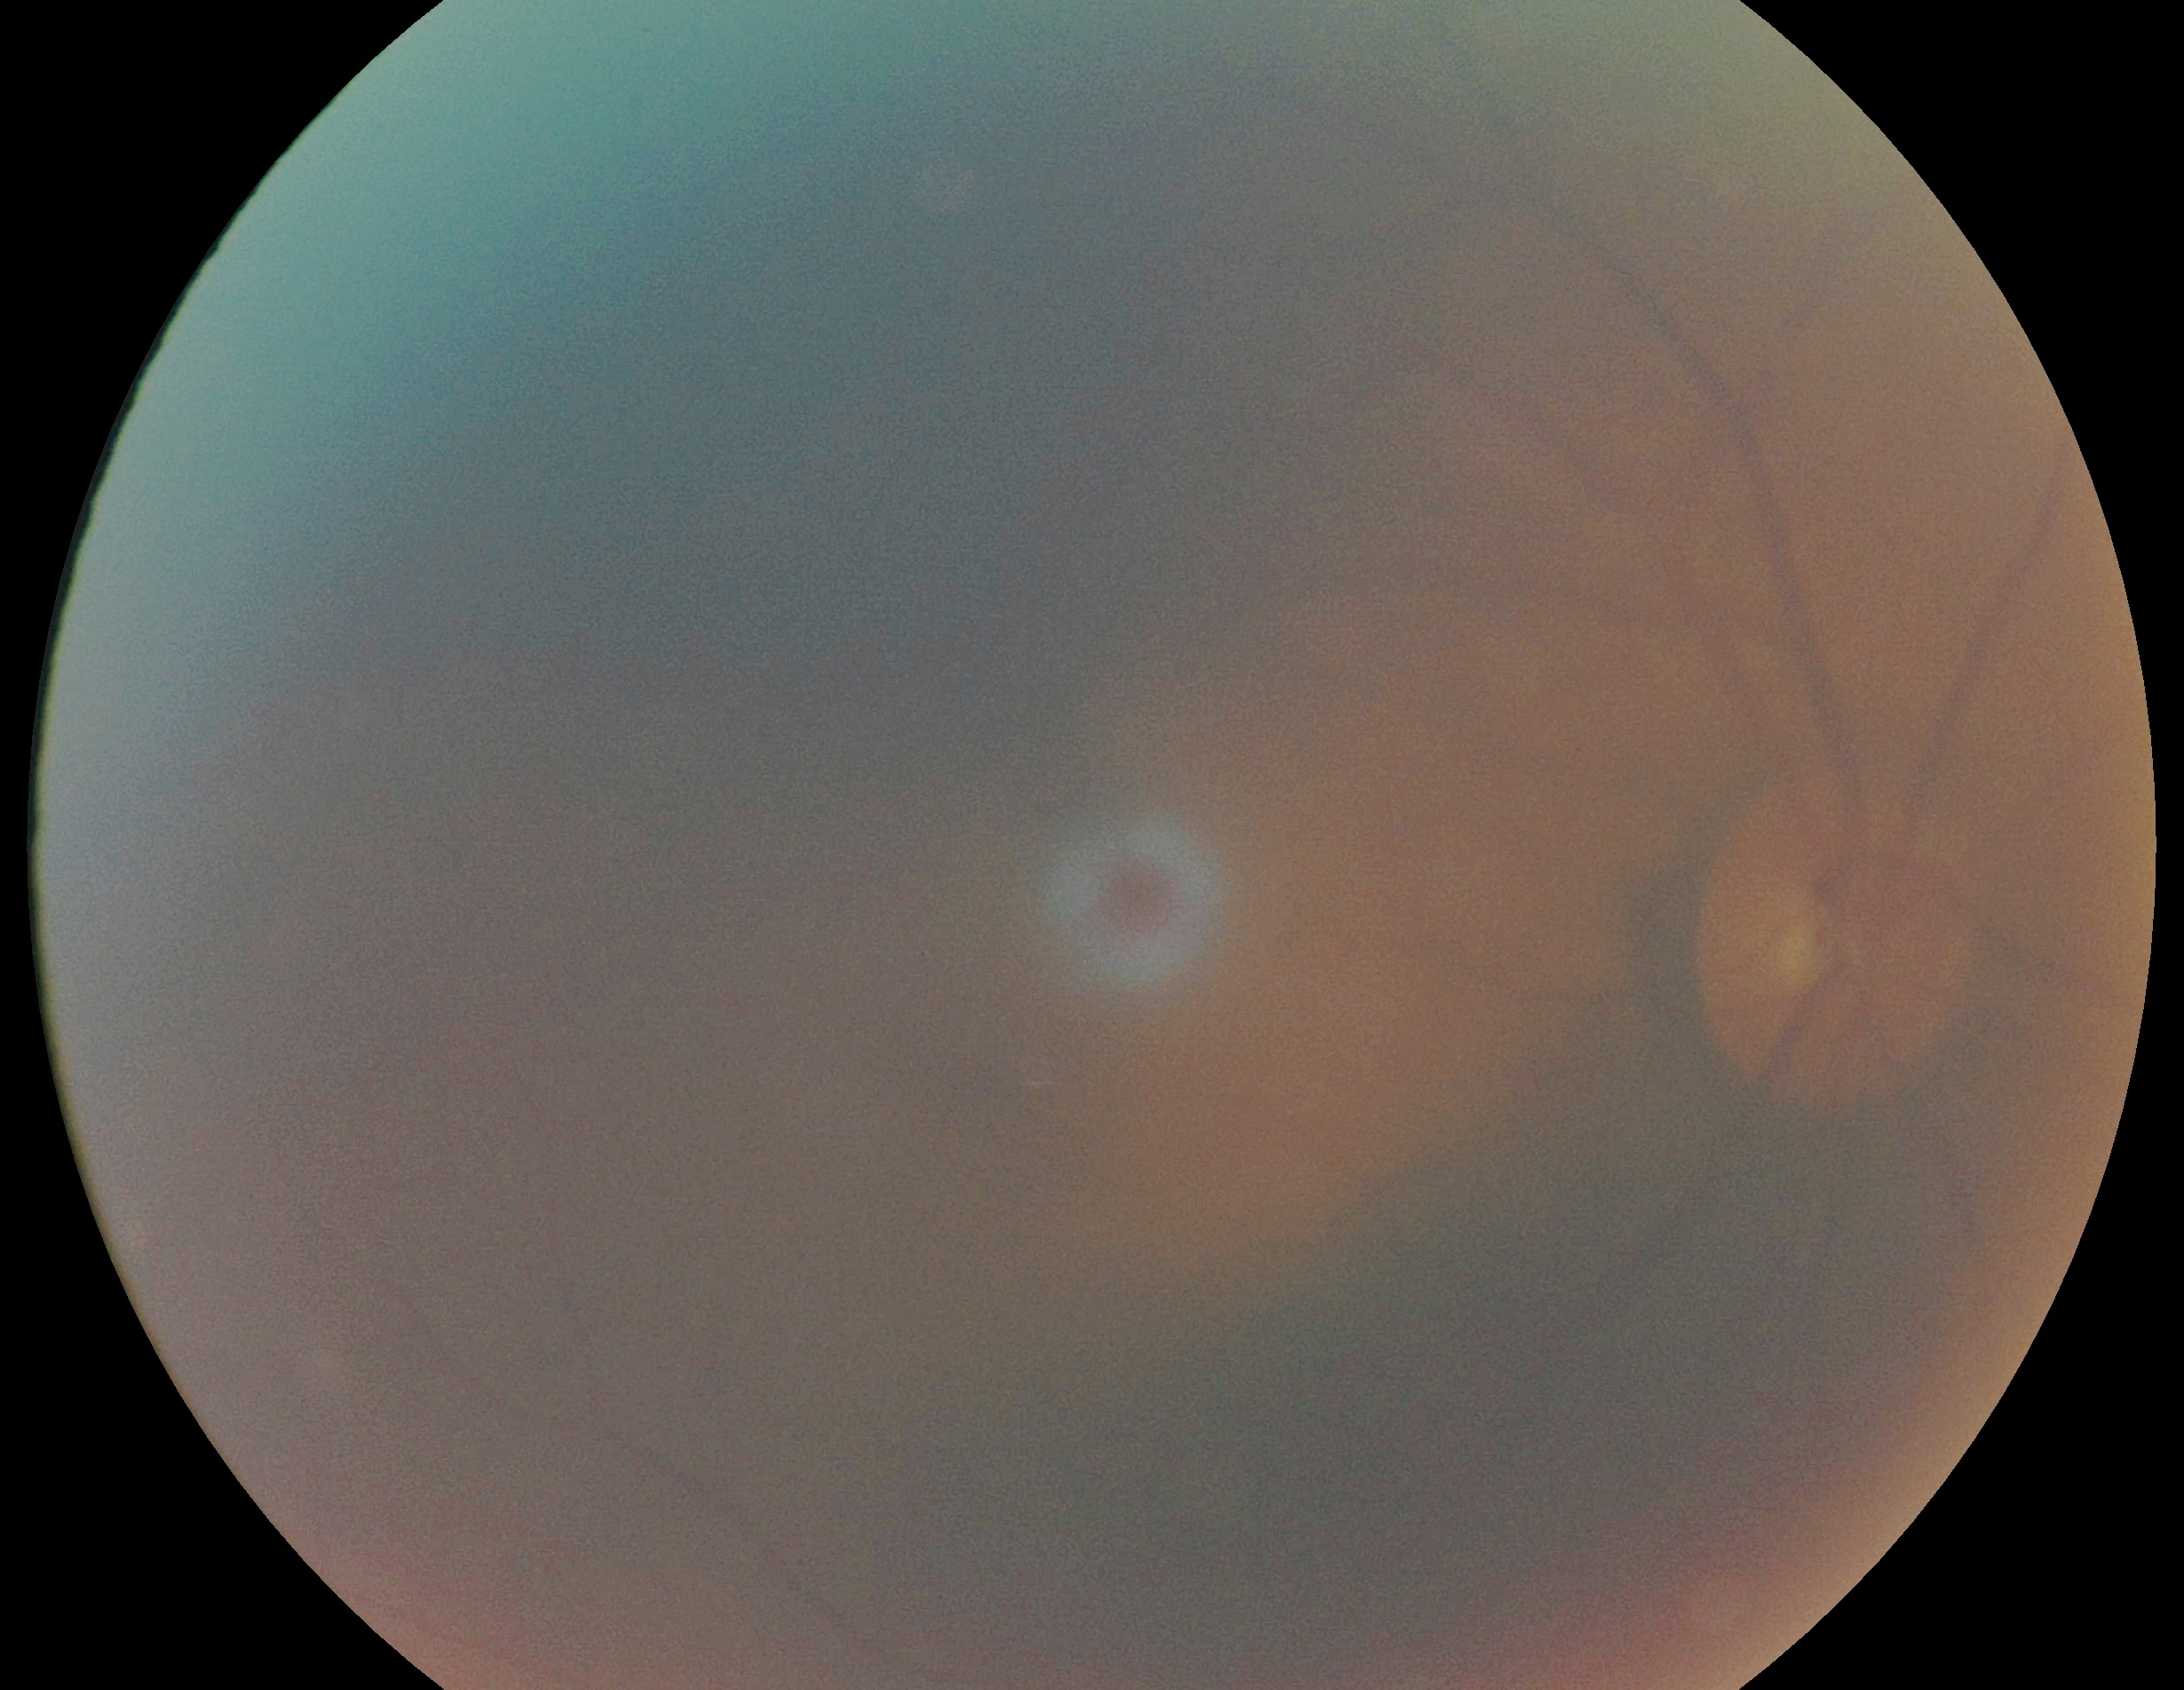

DR grade: ungradable due to poor image quality. The image cannot be graded for diabetic retinopathy.